Camera: Clarity RetCam 3 (130° FOV) · wide-field fundus photograph from neonatal ROP screening — 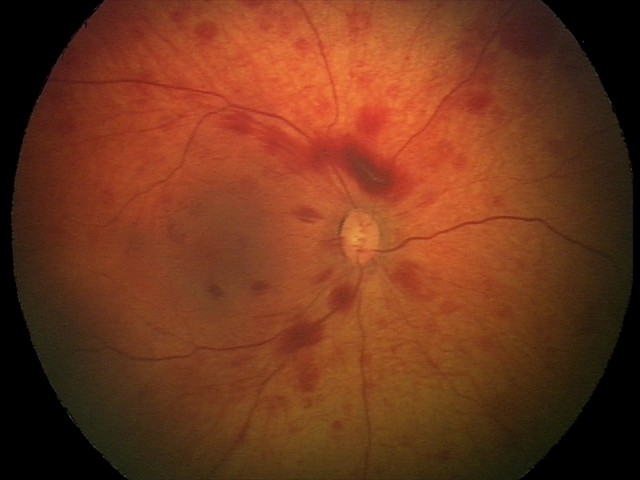
Q: What is the screening diagnosis?
A: retinal hemorrhages